DR severity per modified Davis staging:
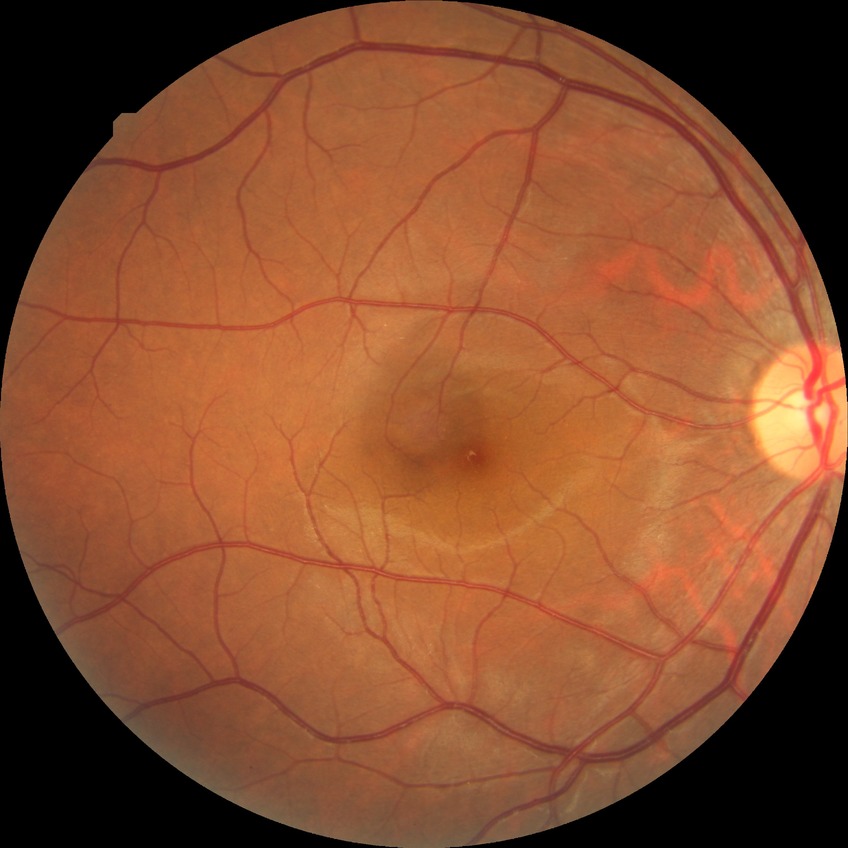
No diabetic retinal disease findings.
Davis grade is NDR.